Topcon TRC-NW8; fundus photo; 50° field of view: 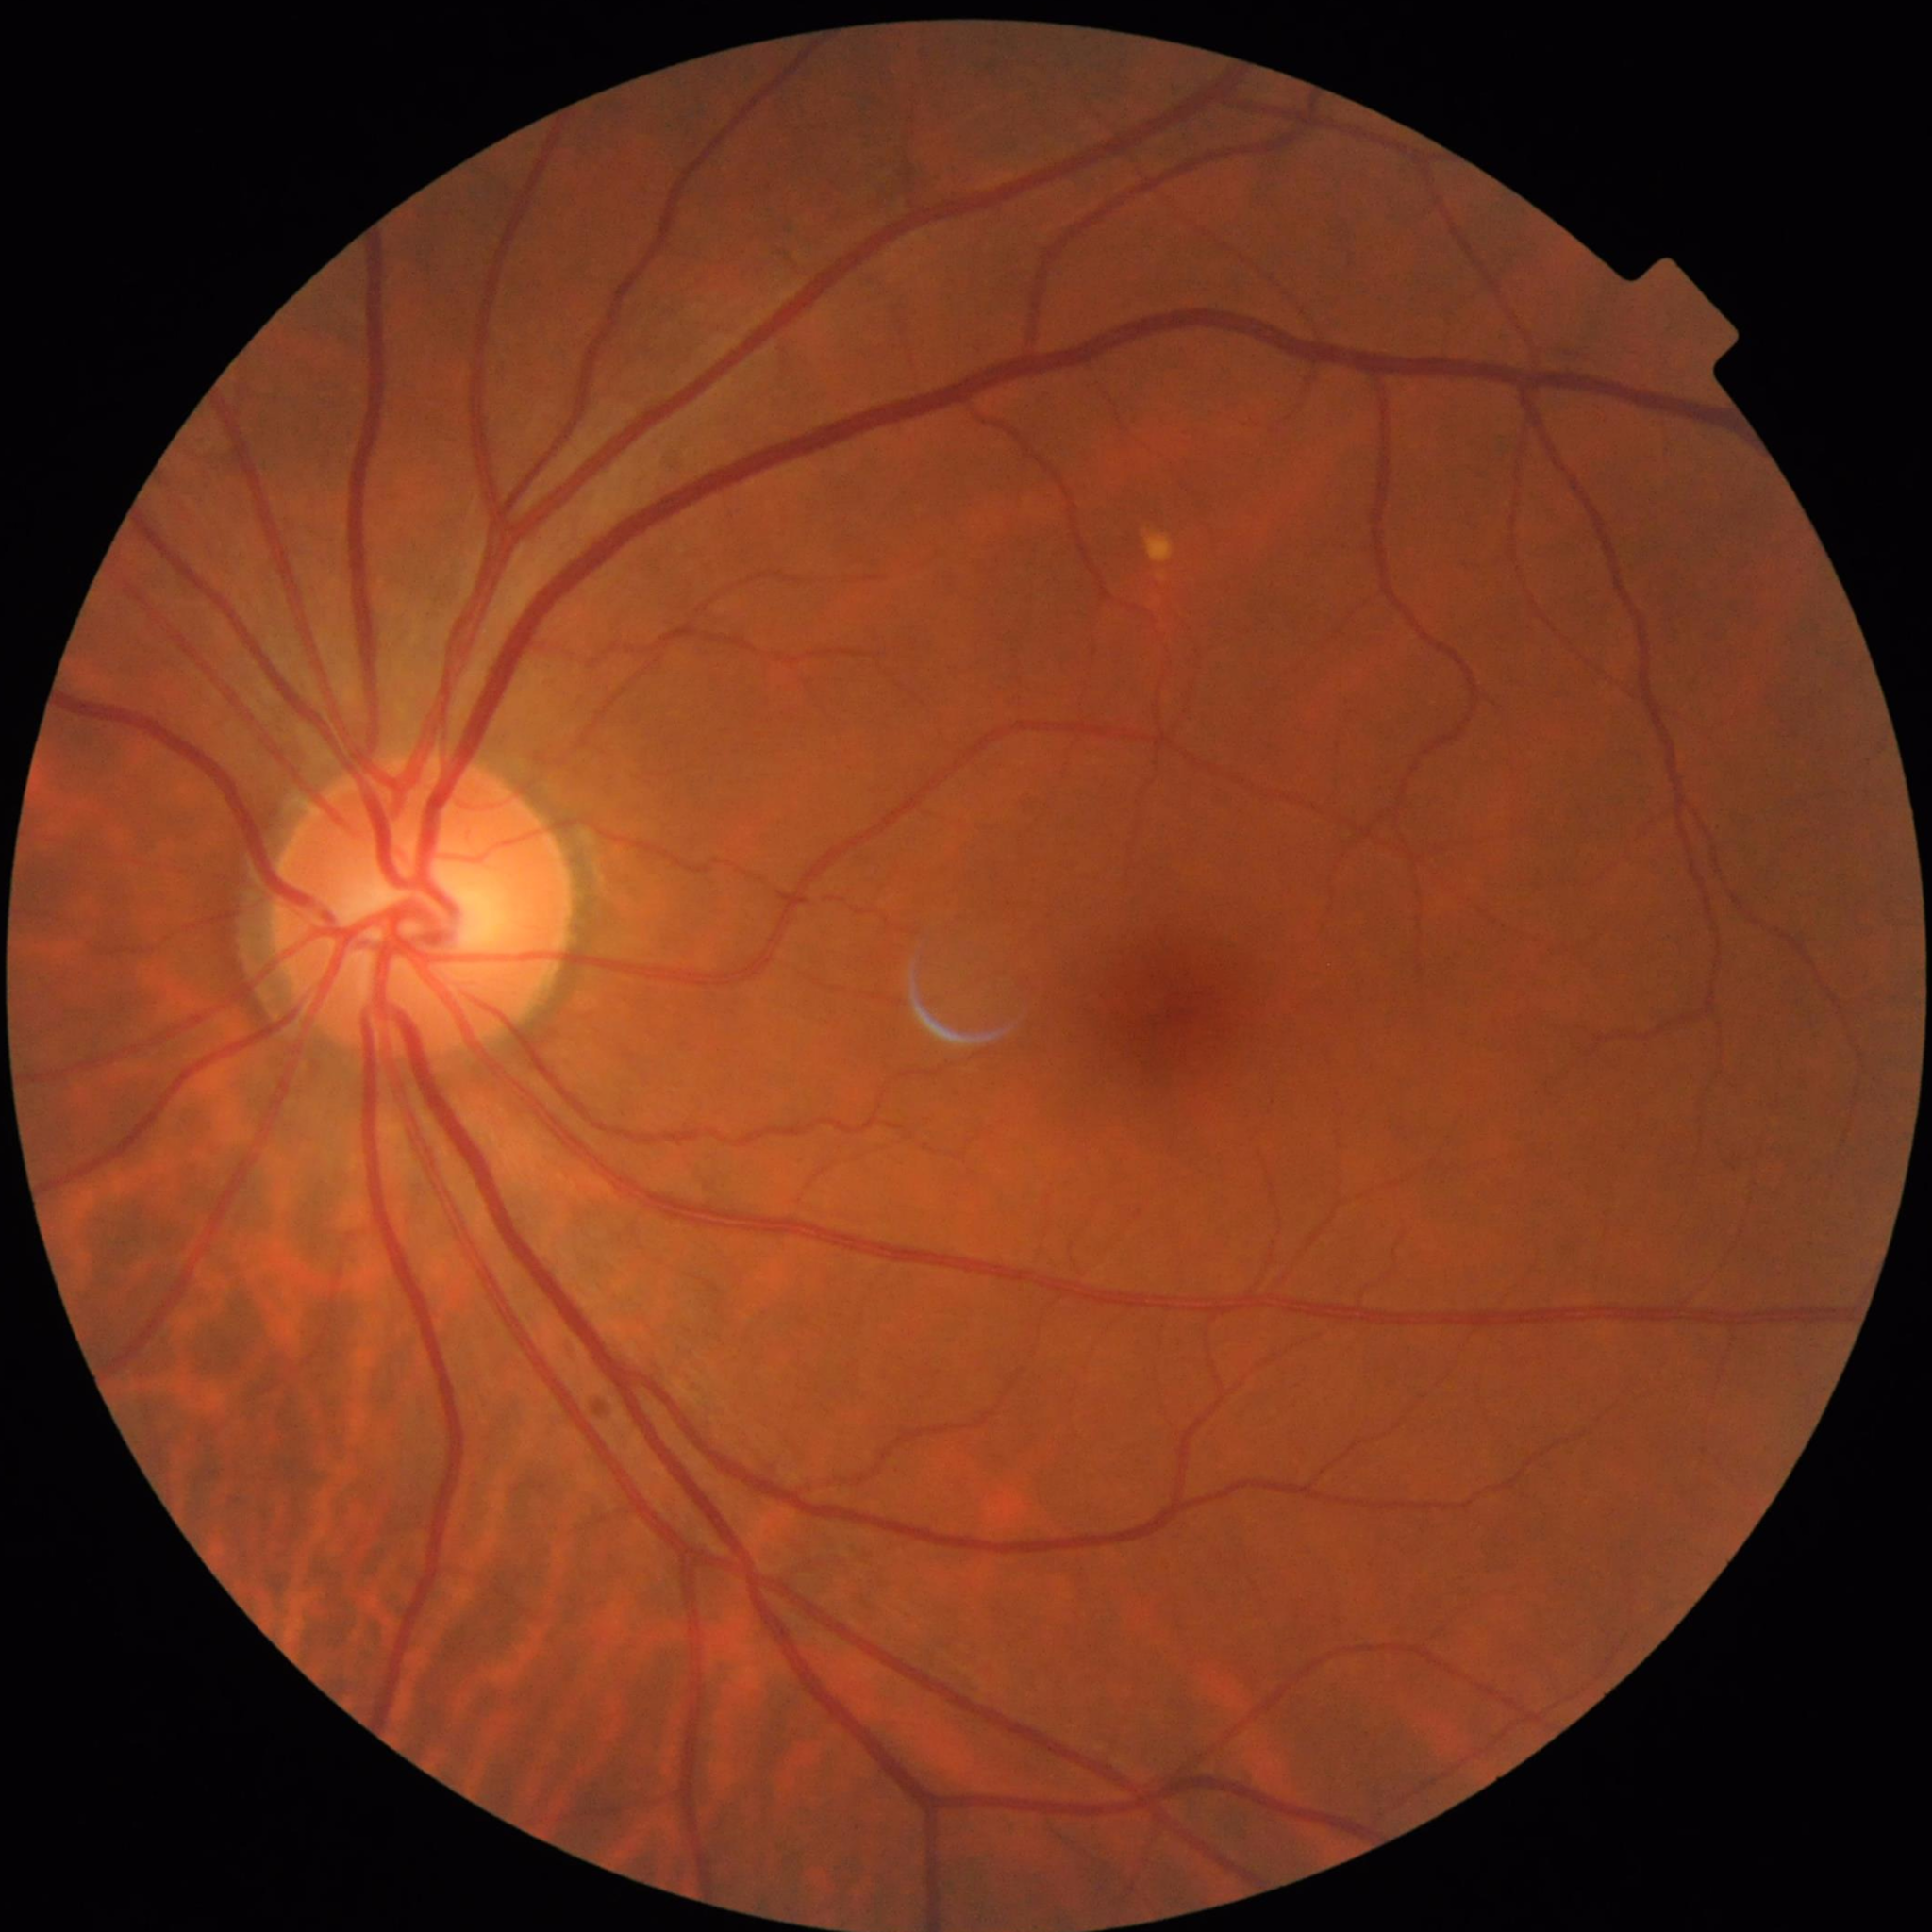

Quality assessment: no quality issues identified.
No AMD, DR, or glaucomatous findings.